Portable fundus camera image
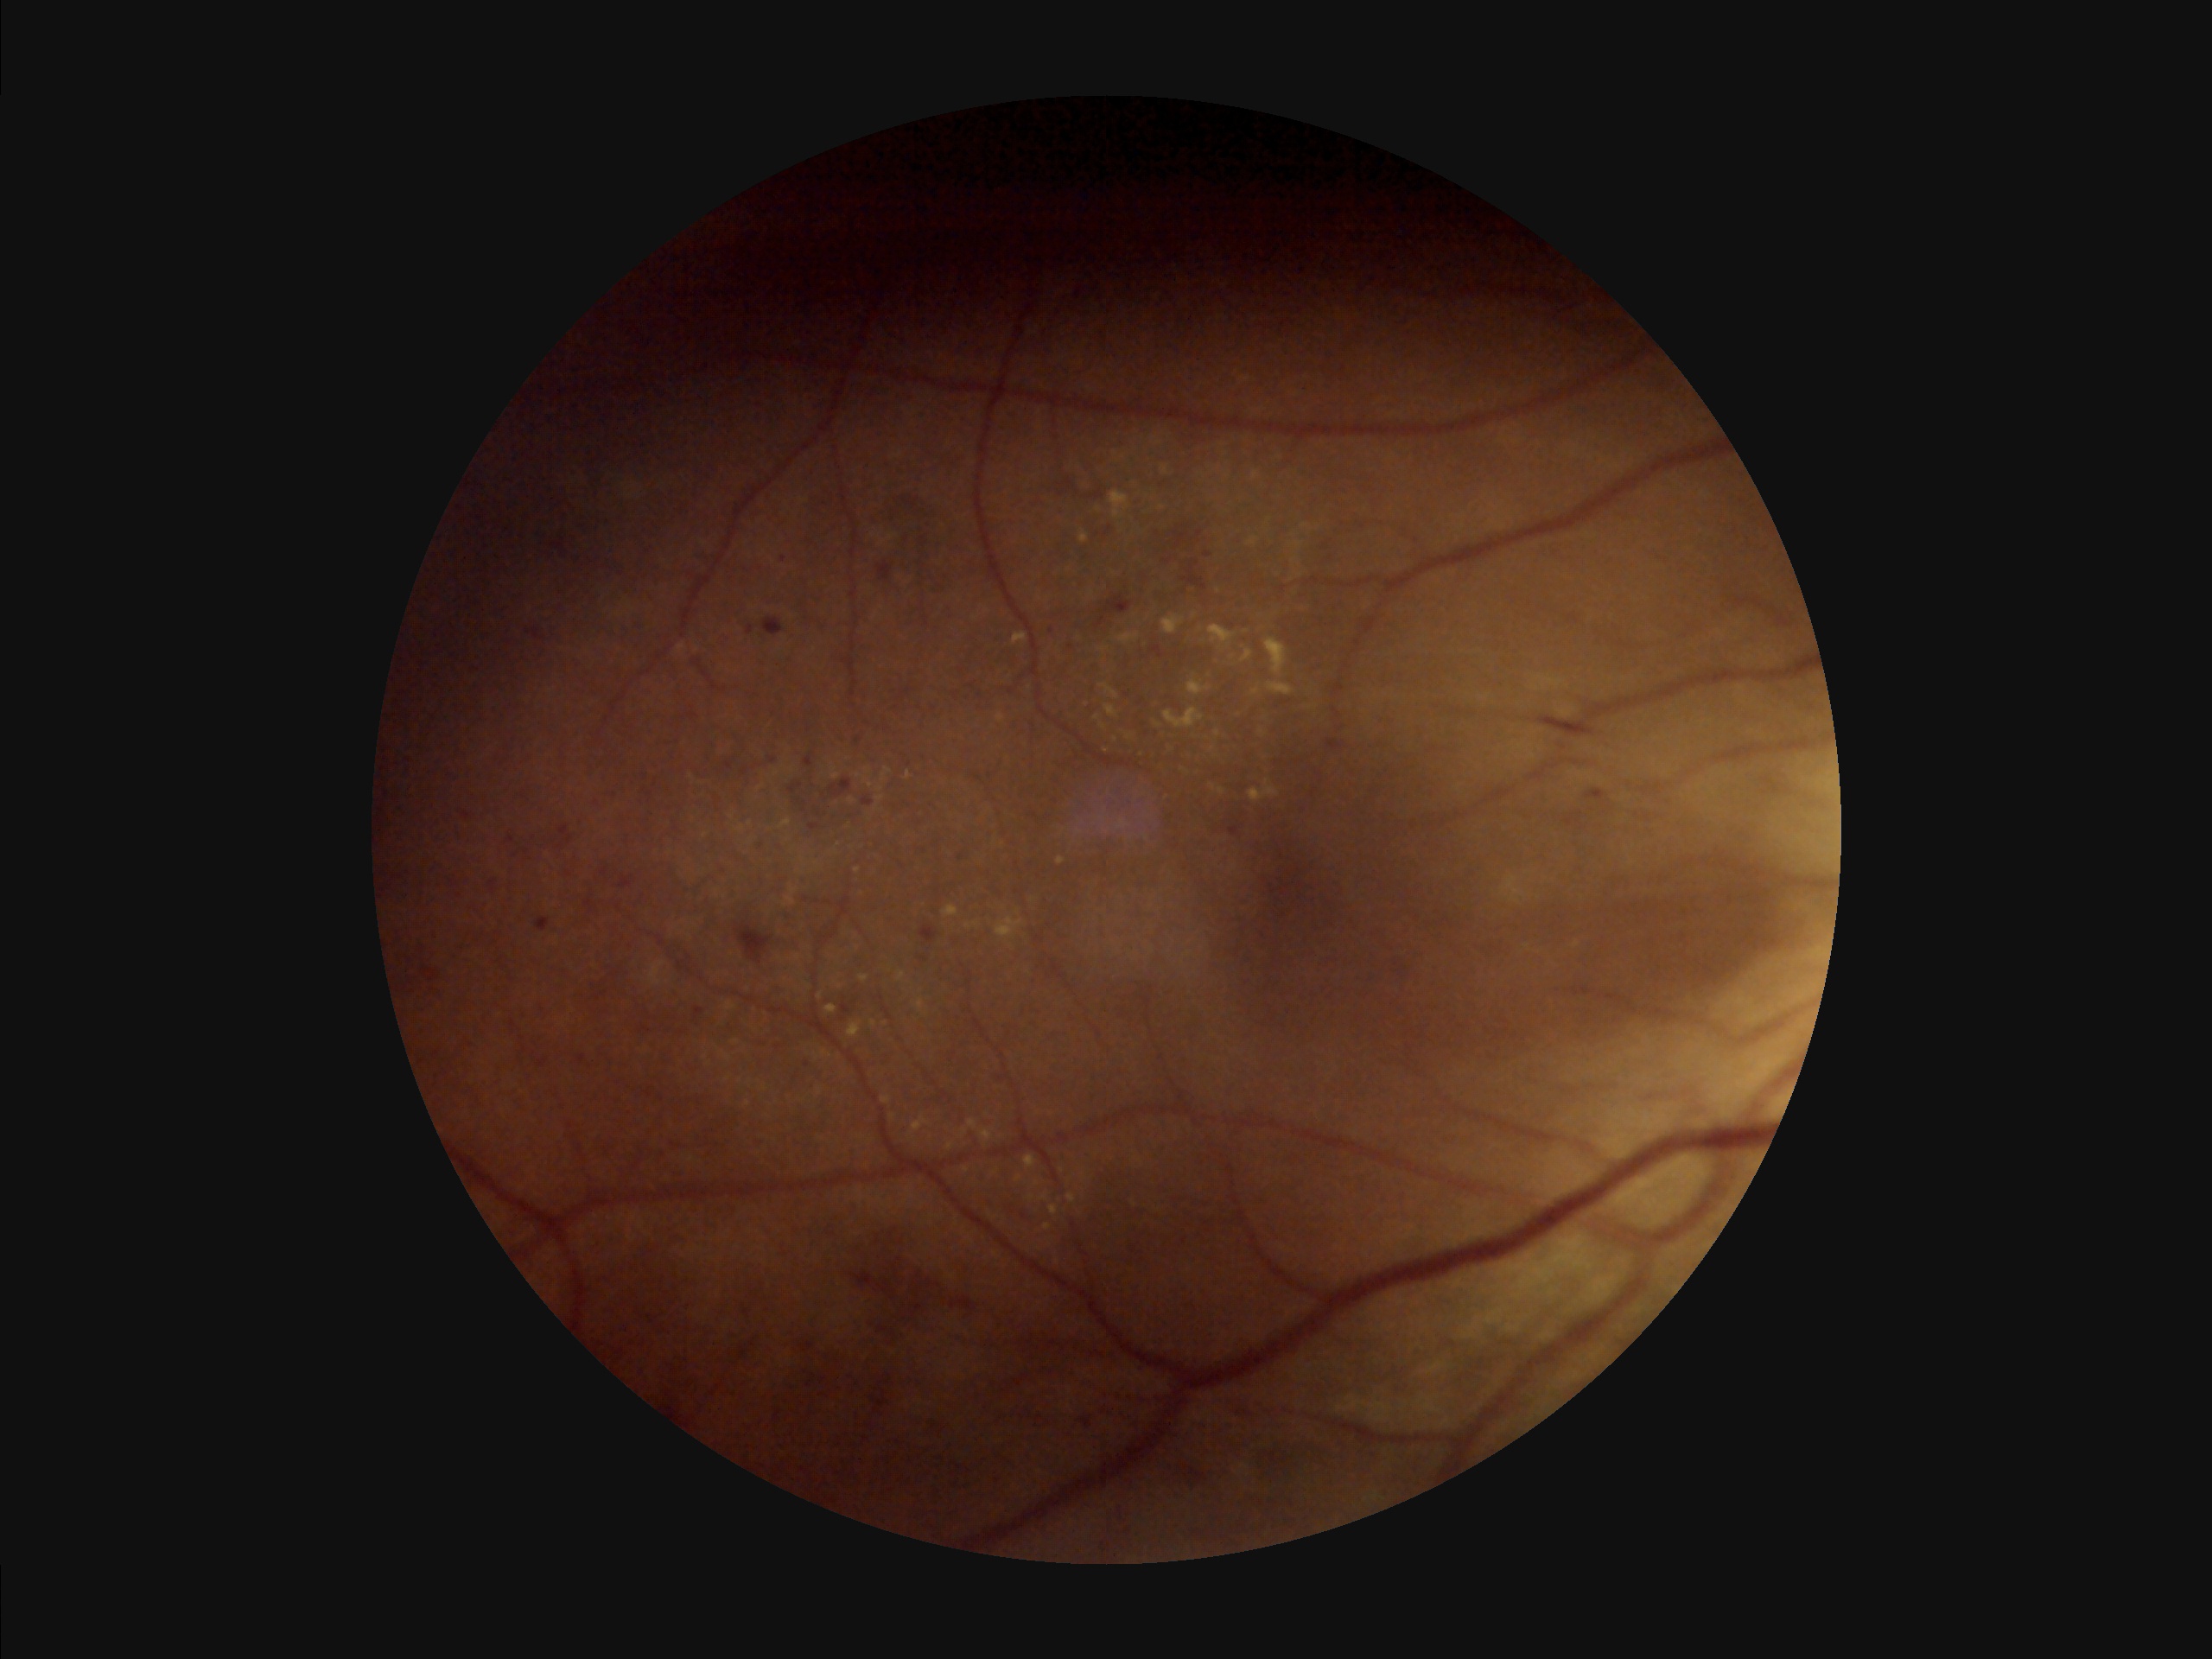

Optic disc, vessels, and background are in focus. Image quality is suboptimal. Vessels and details are hard to distinguish. Illumination is uneven.